Color fundus photograph; without pupil dilation; graded on the modified Davis scale; 45° field of view; acquired with a NIDEK AFC-230.
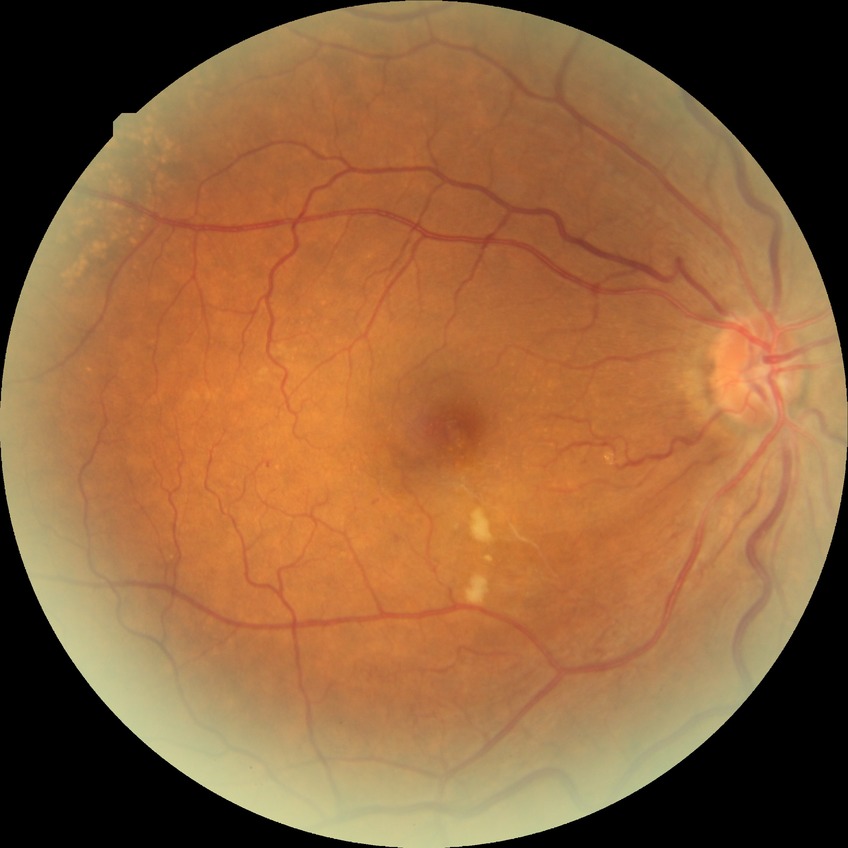
Diabetic retinopathy (DR) is no diabetic retinopathy (NDR).